1659 x 2212 pixels, fundus photo.
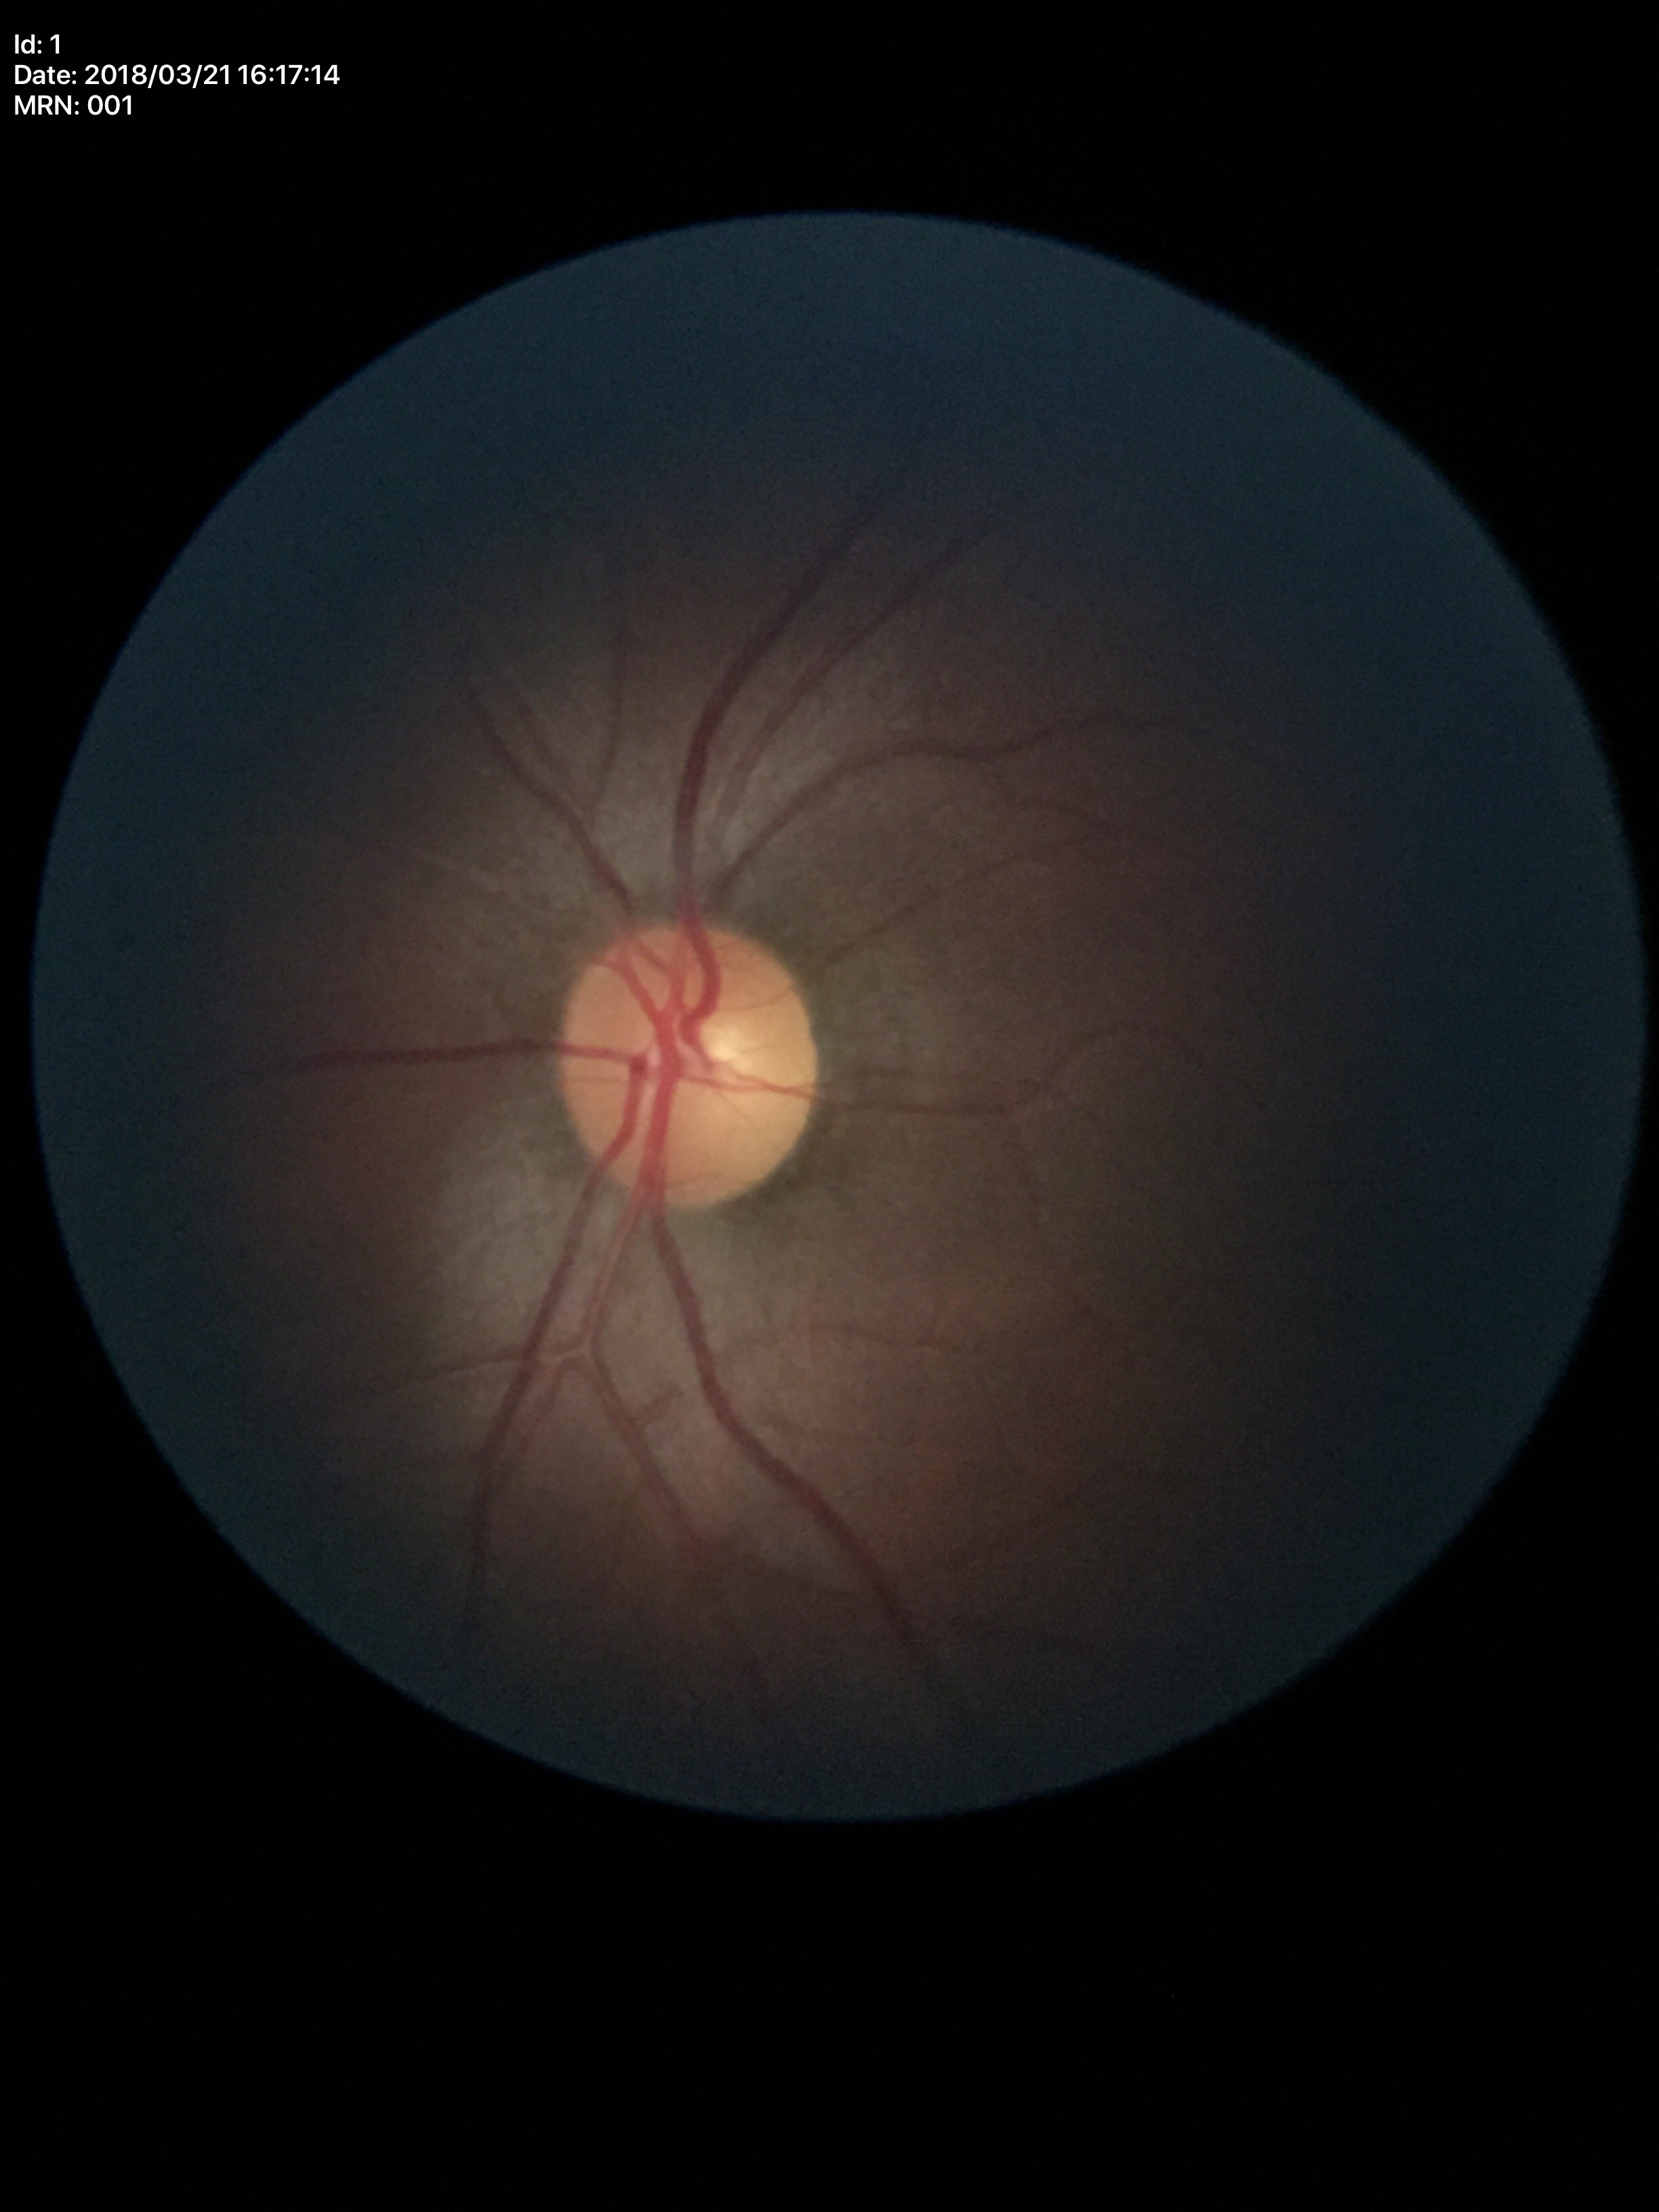

Optic disc analysis:
– Glaucoma impression · negative (5/5 ophthalmologists in agreement)
– HCDR · 0.49
– VCDR · 0.46